2352 x 1568 pixels:
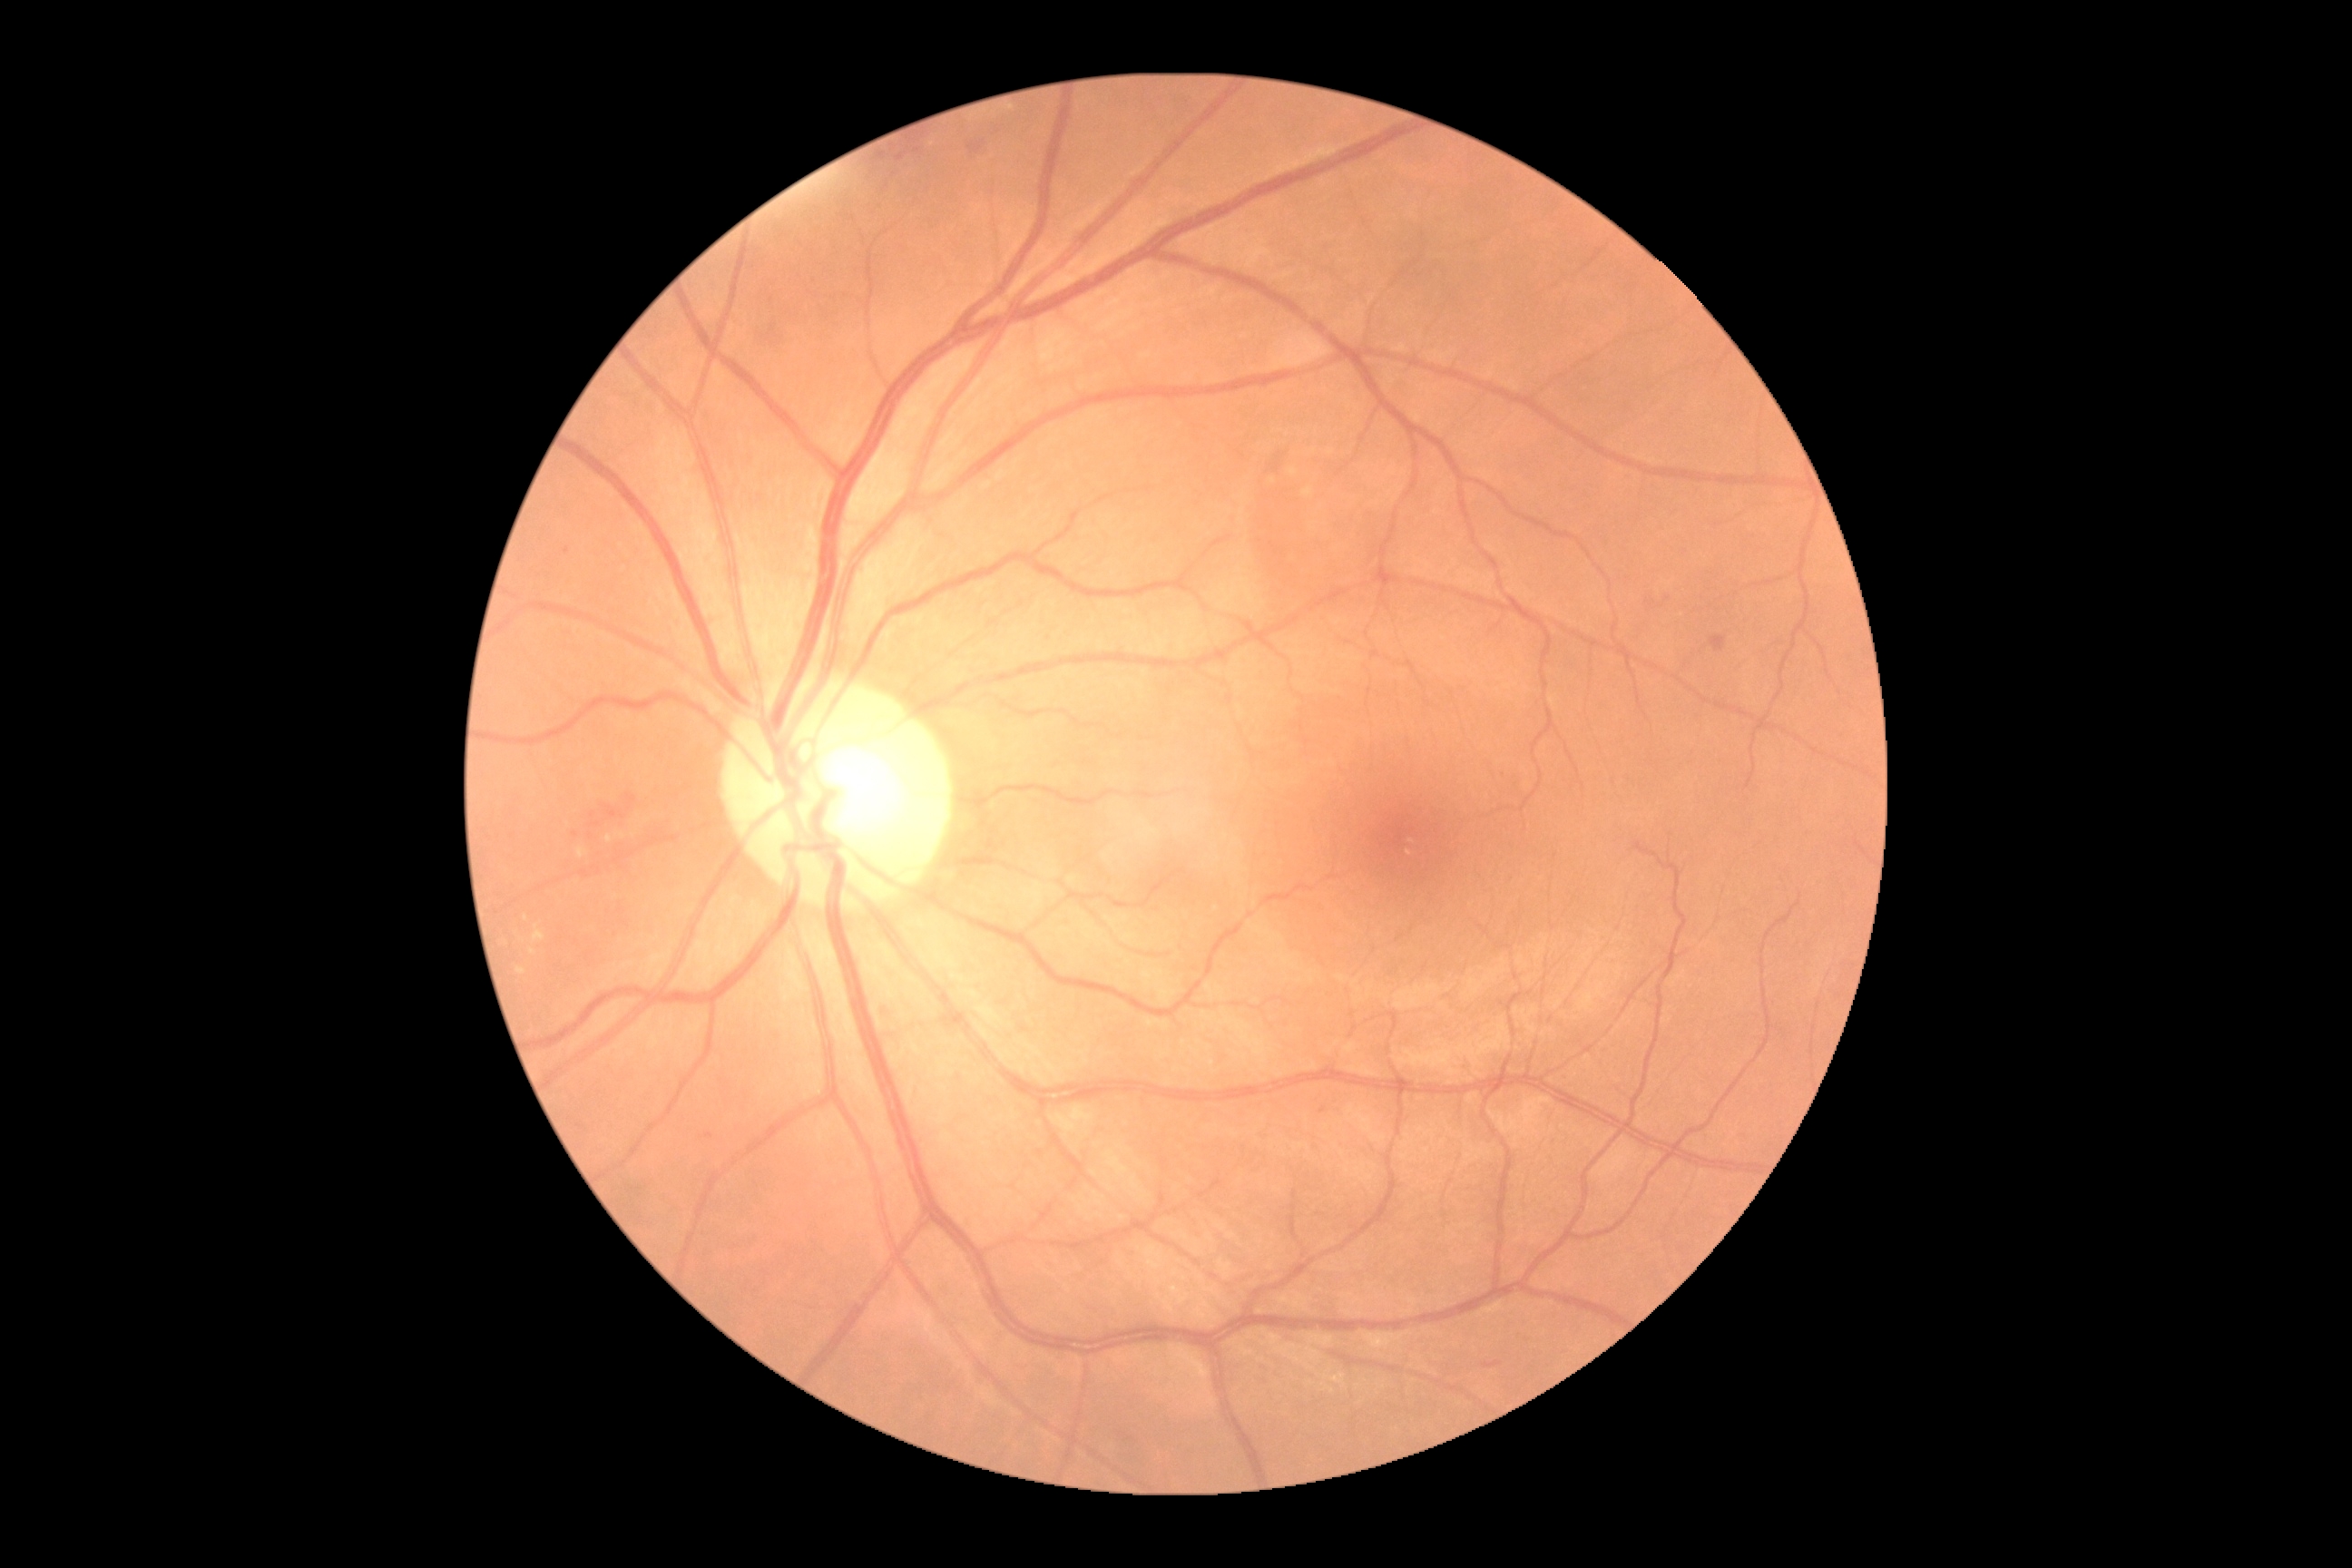

DR stage: grade 2 (moderate NPDR).